Diabetic retinopathy graded by the modified Davis classification: 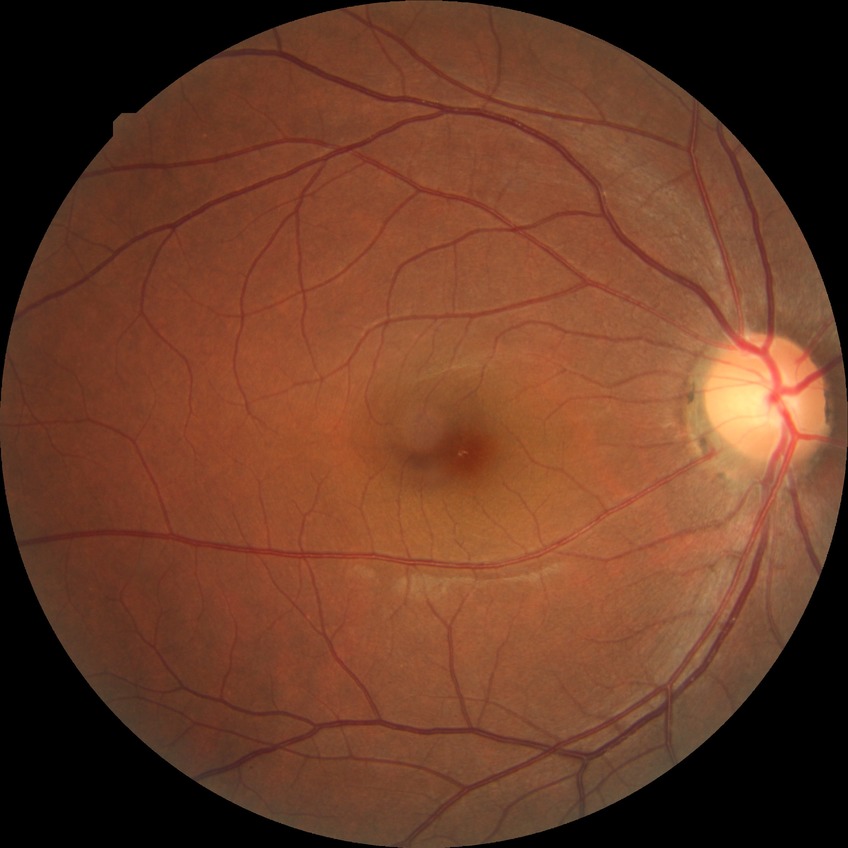 modified Davis classification: no diabetic retinopathy.